Fundus photo, 45-degree field of view — 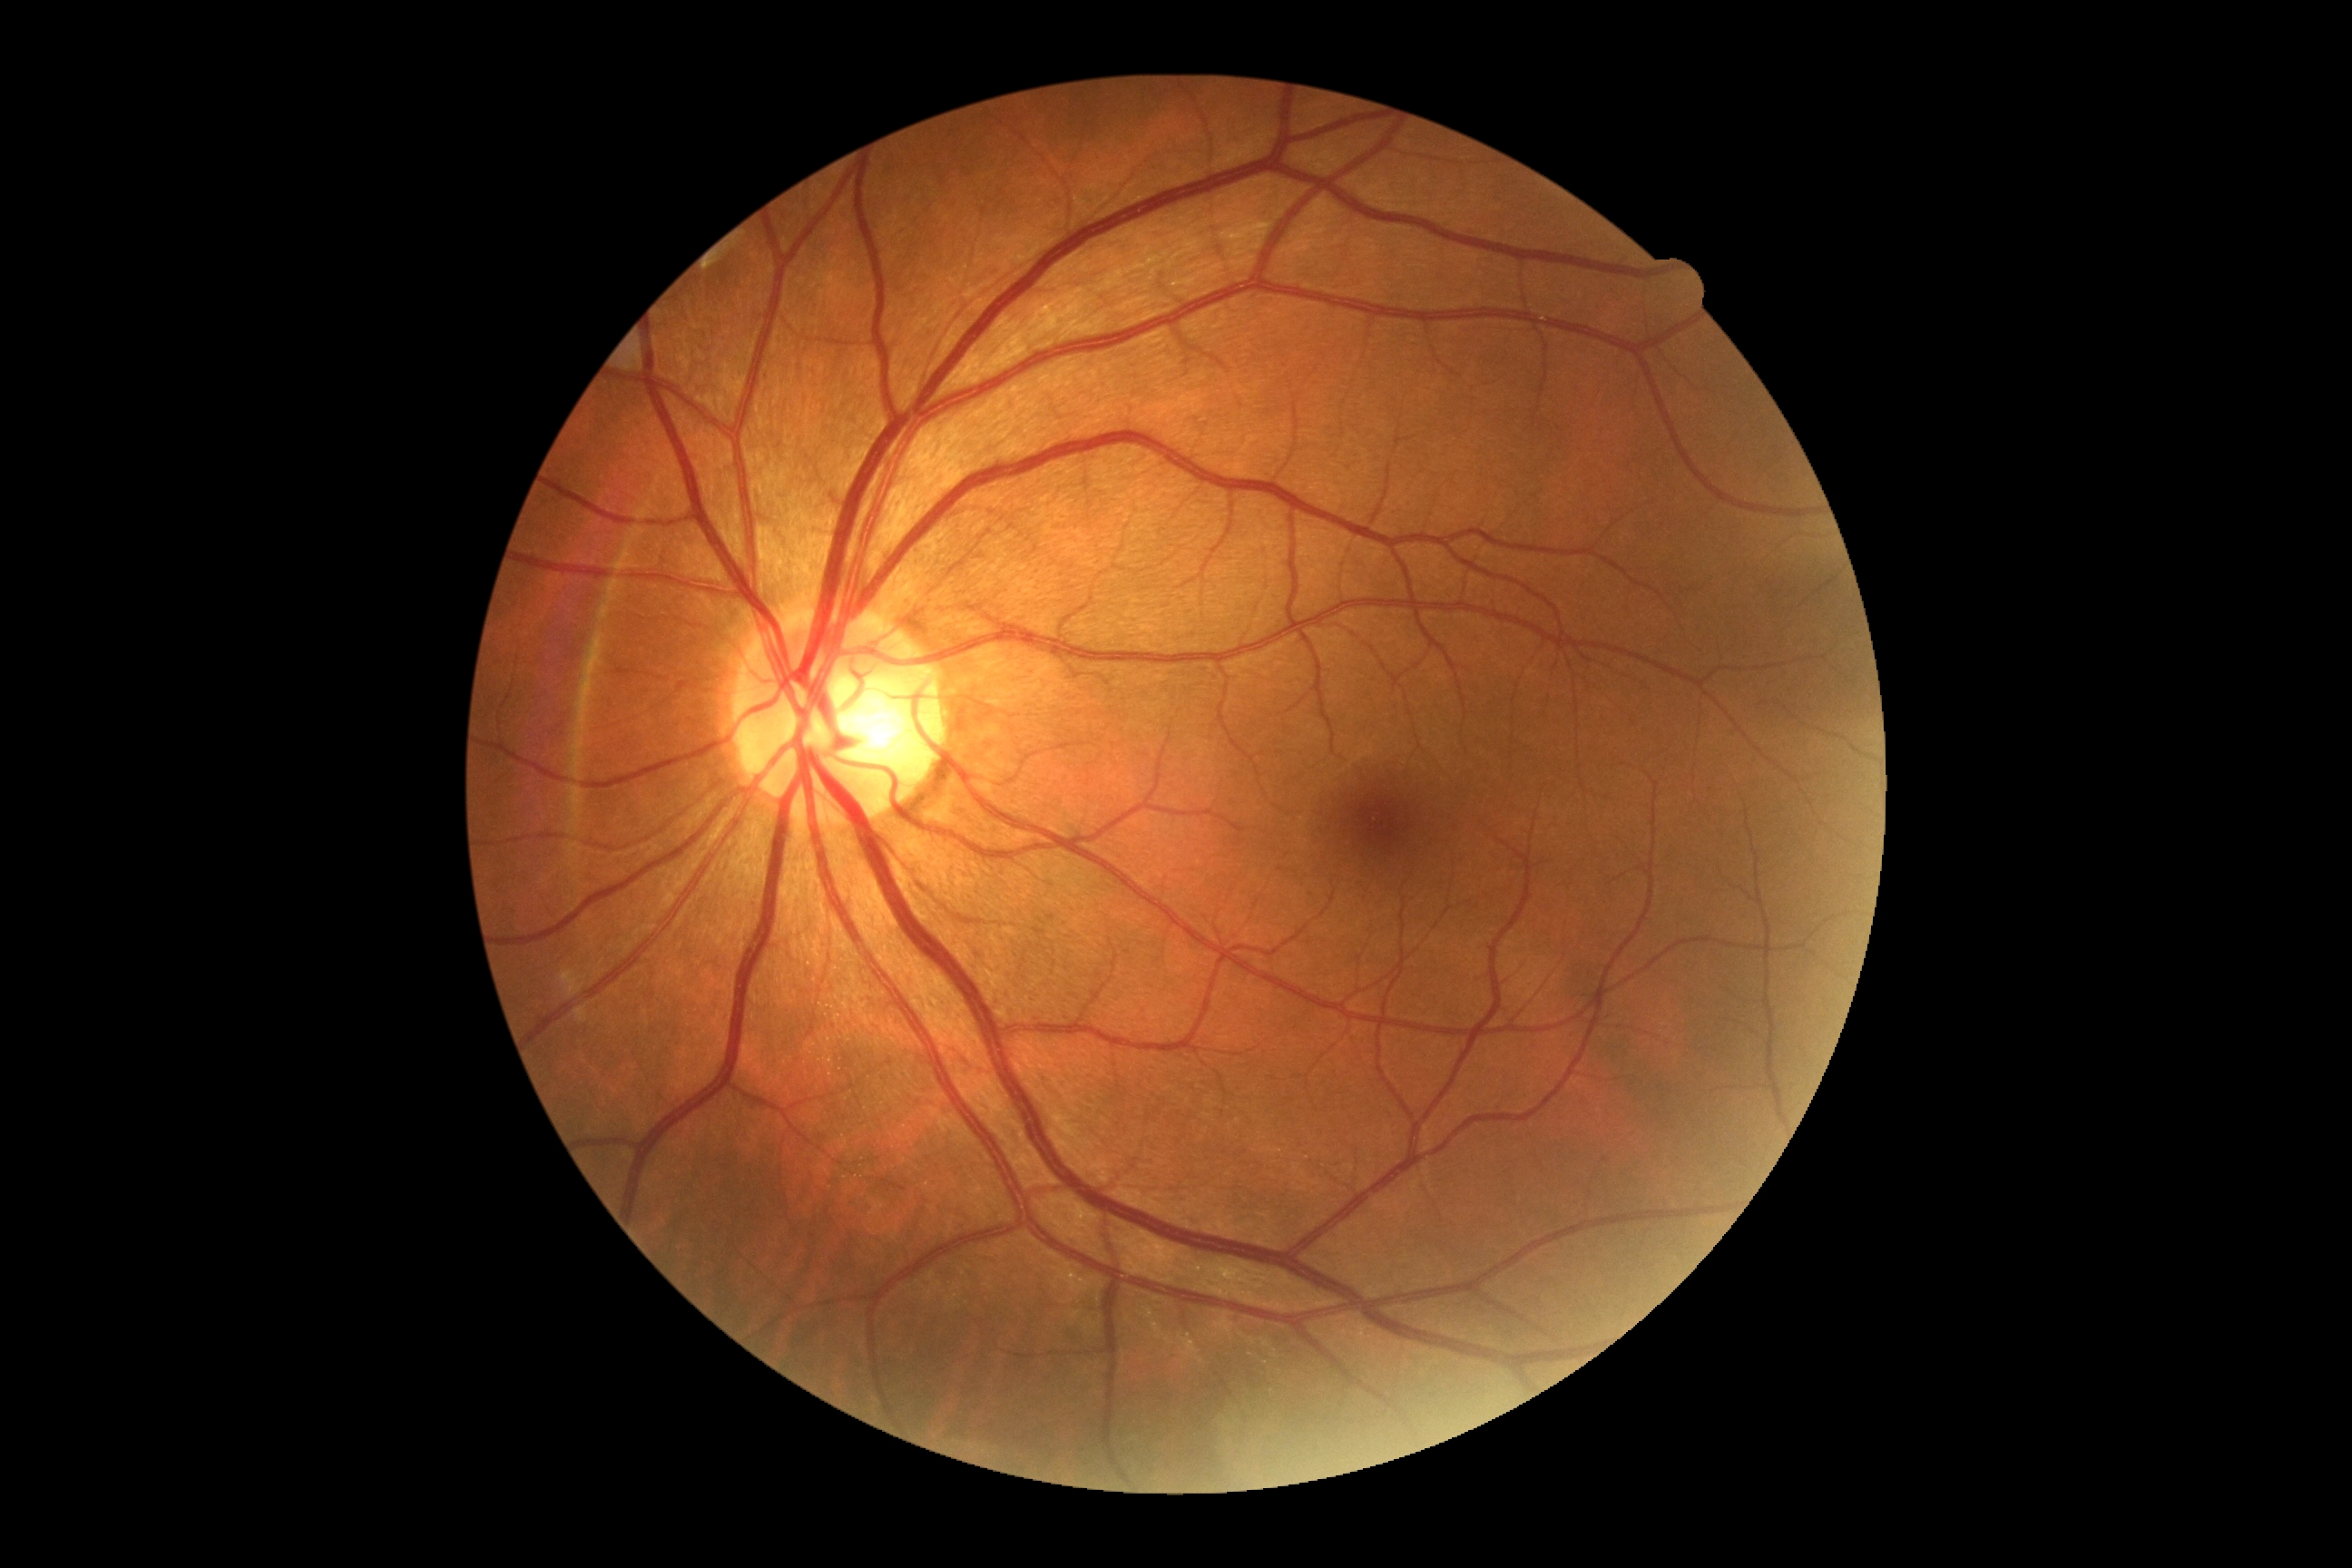
No diabetic retinal disease findings. DR grade is 0.